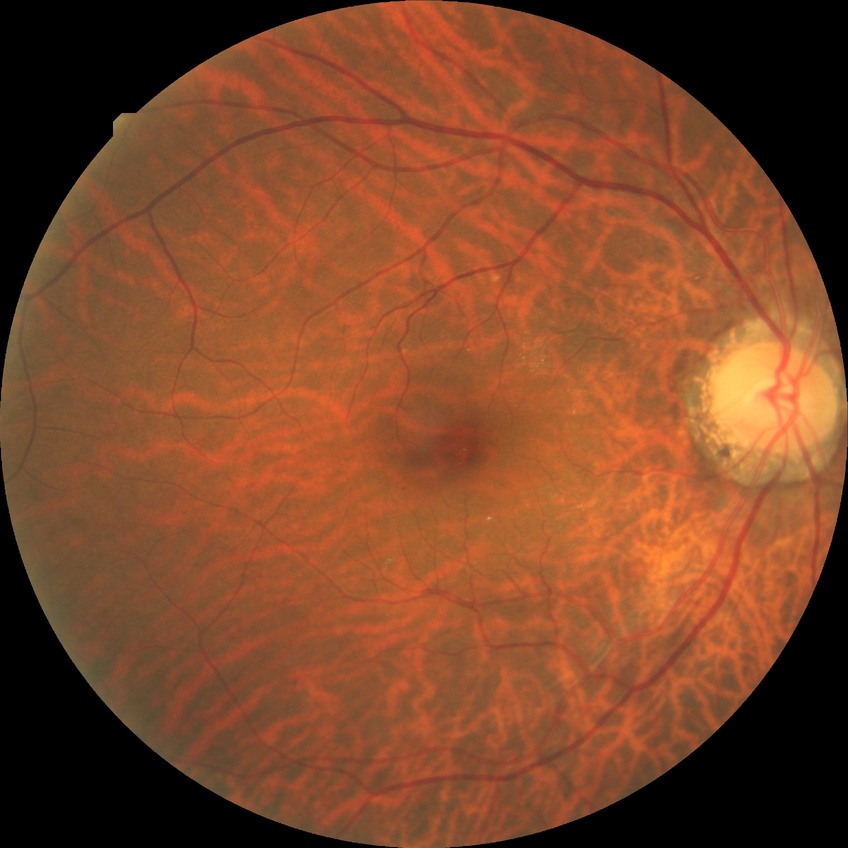 Diabetic retinopathy (DR) is no diabetic retinopathy (NDR).